Image size 1932x1932
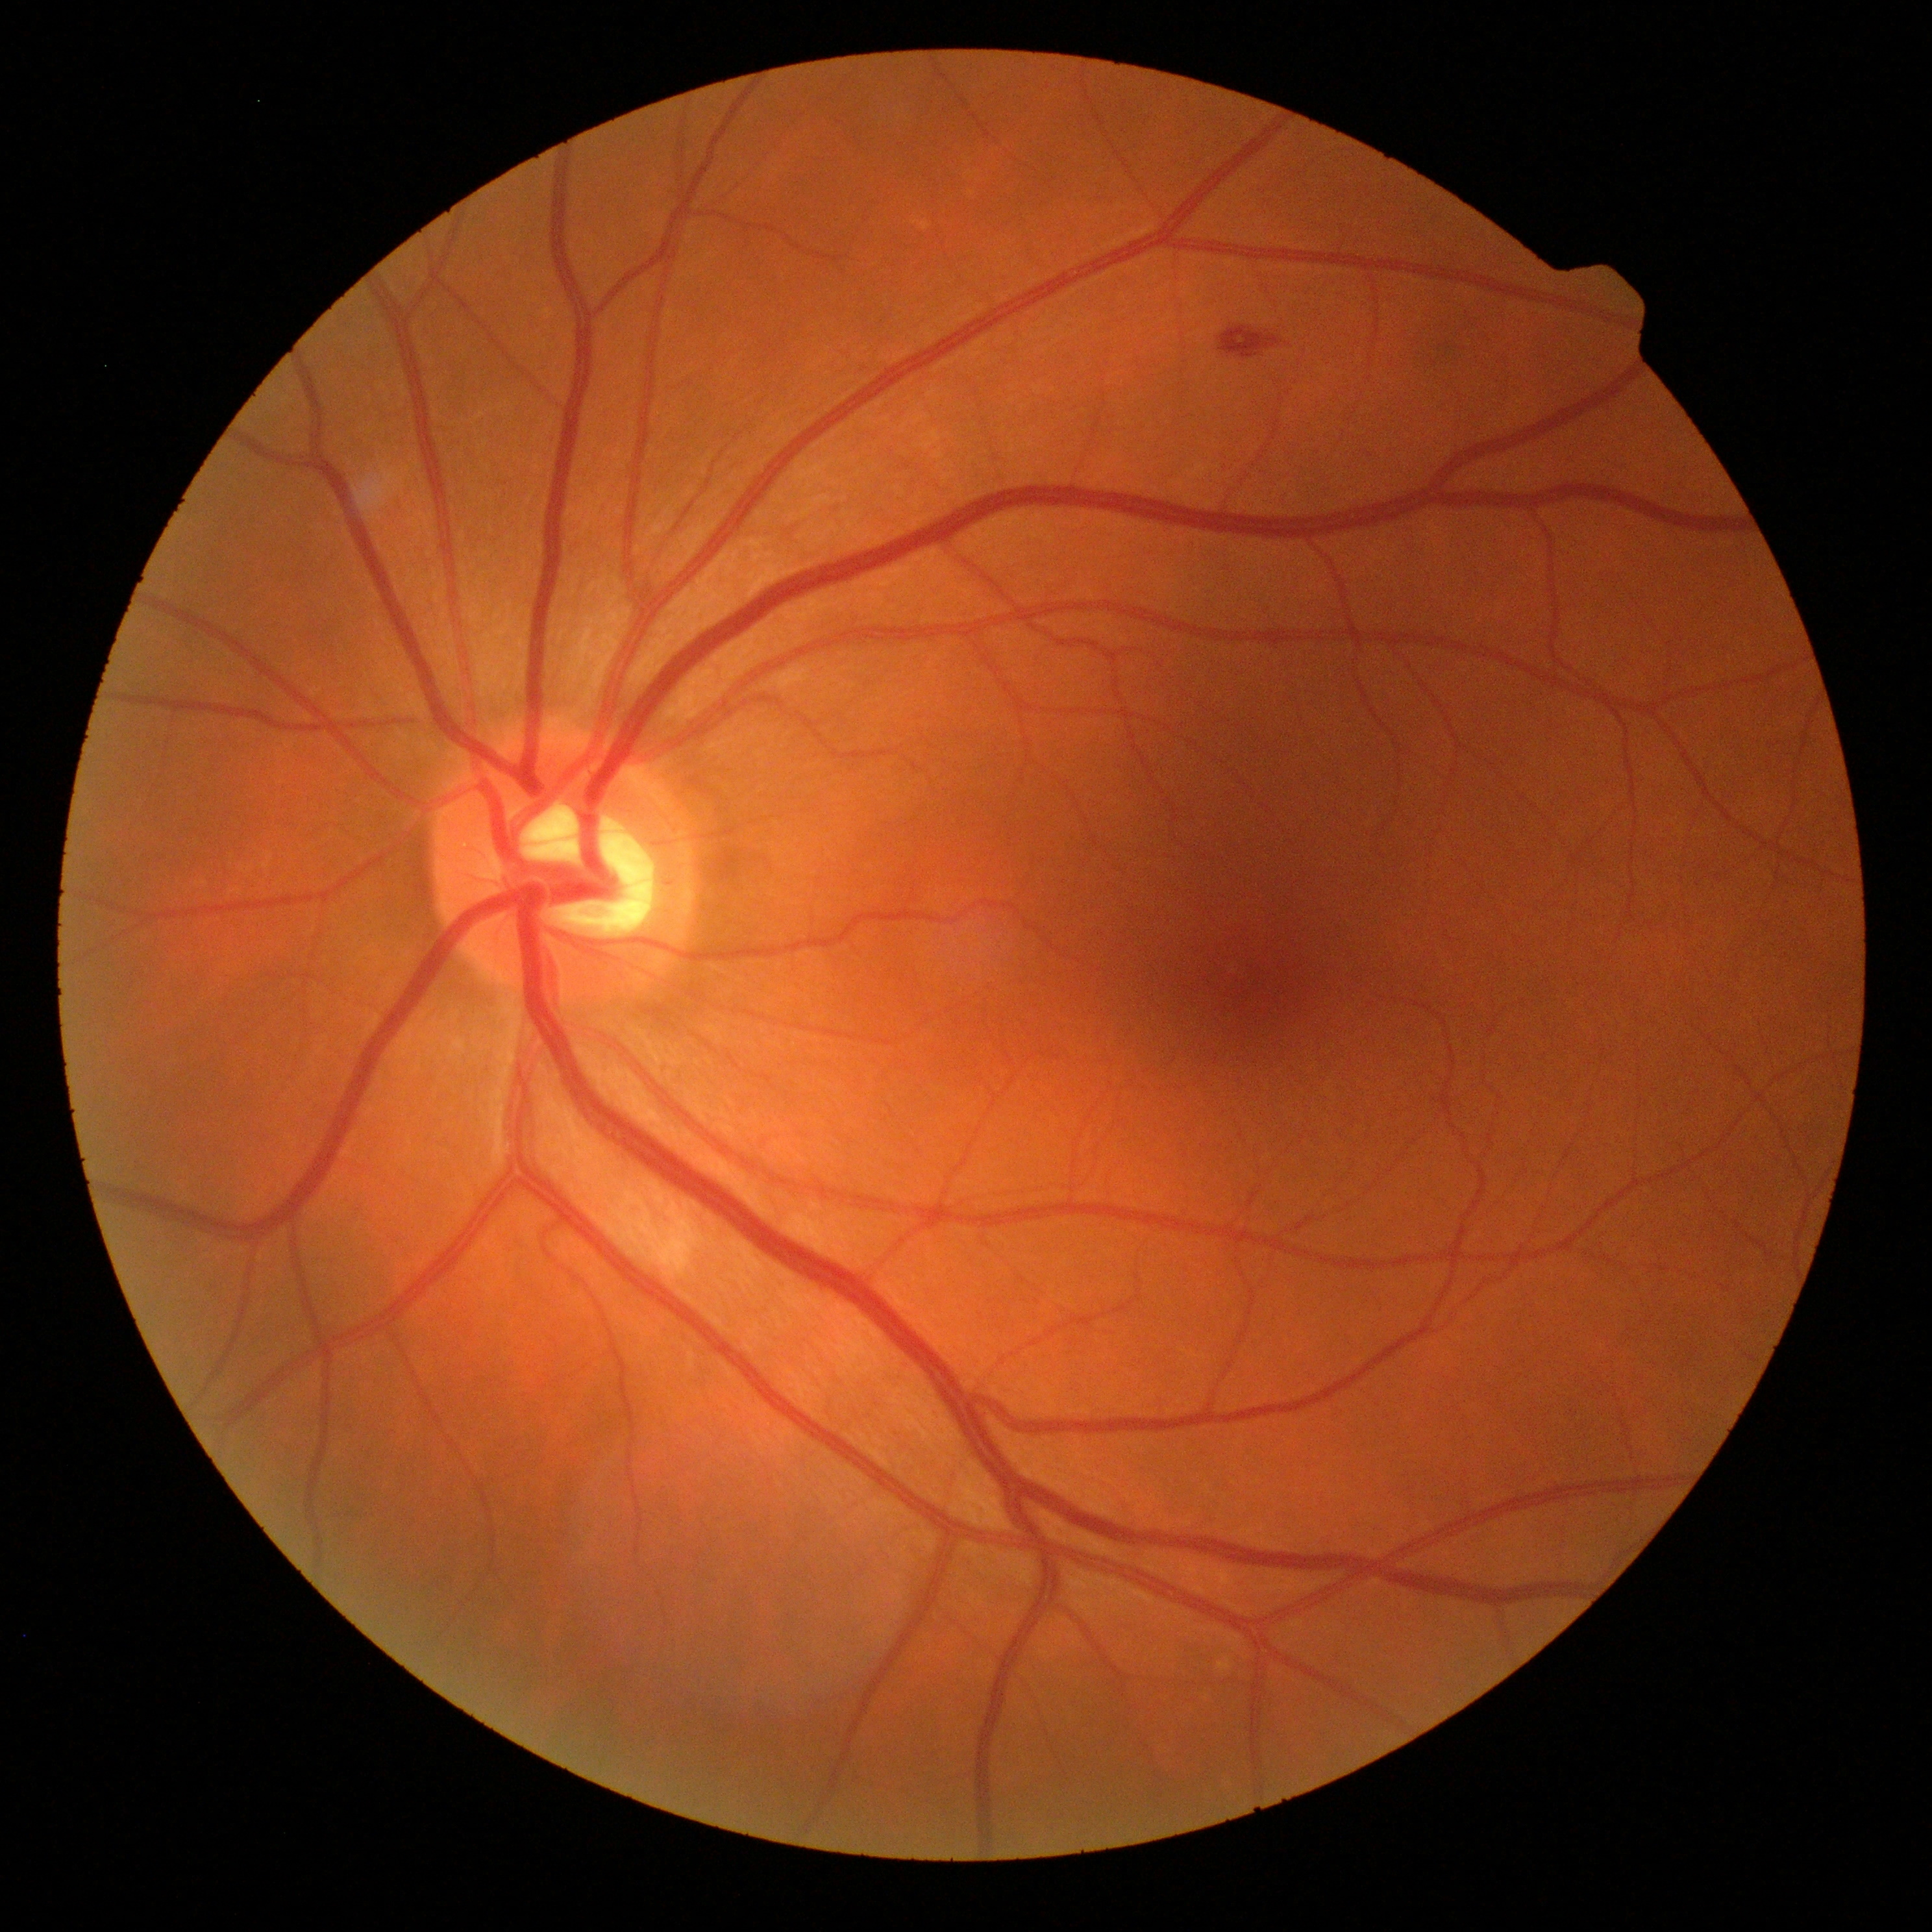 Diabetic retinopathy grade: moderate non-proliferative diabetic retinopathy (2).